Color fundus image:
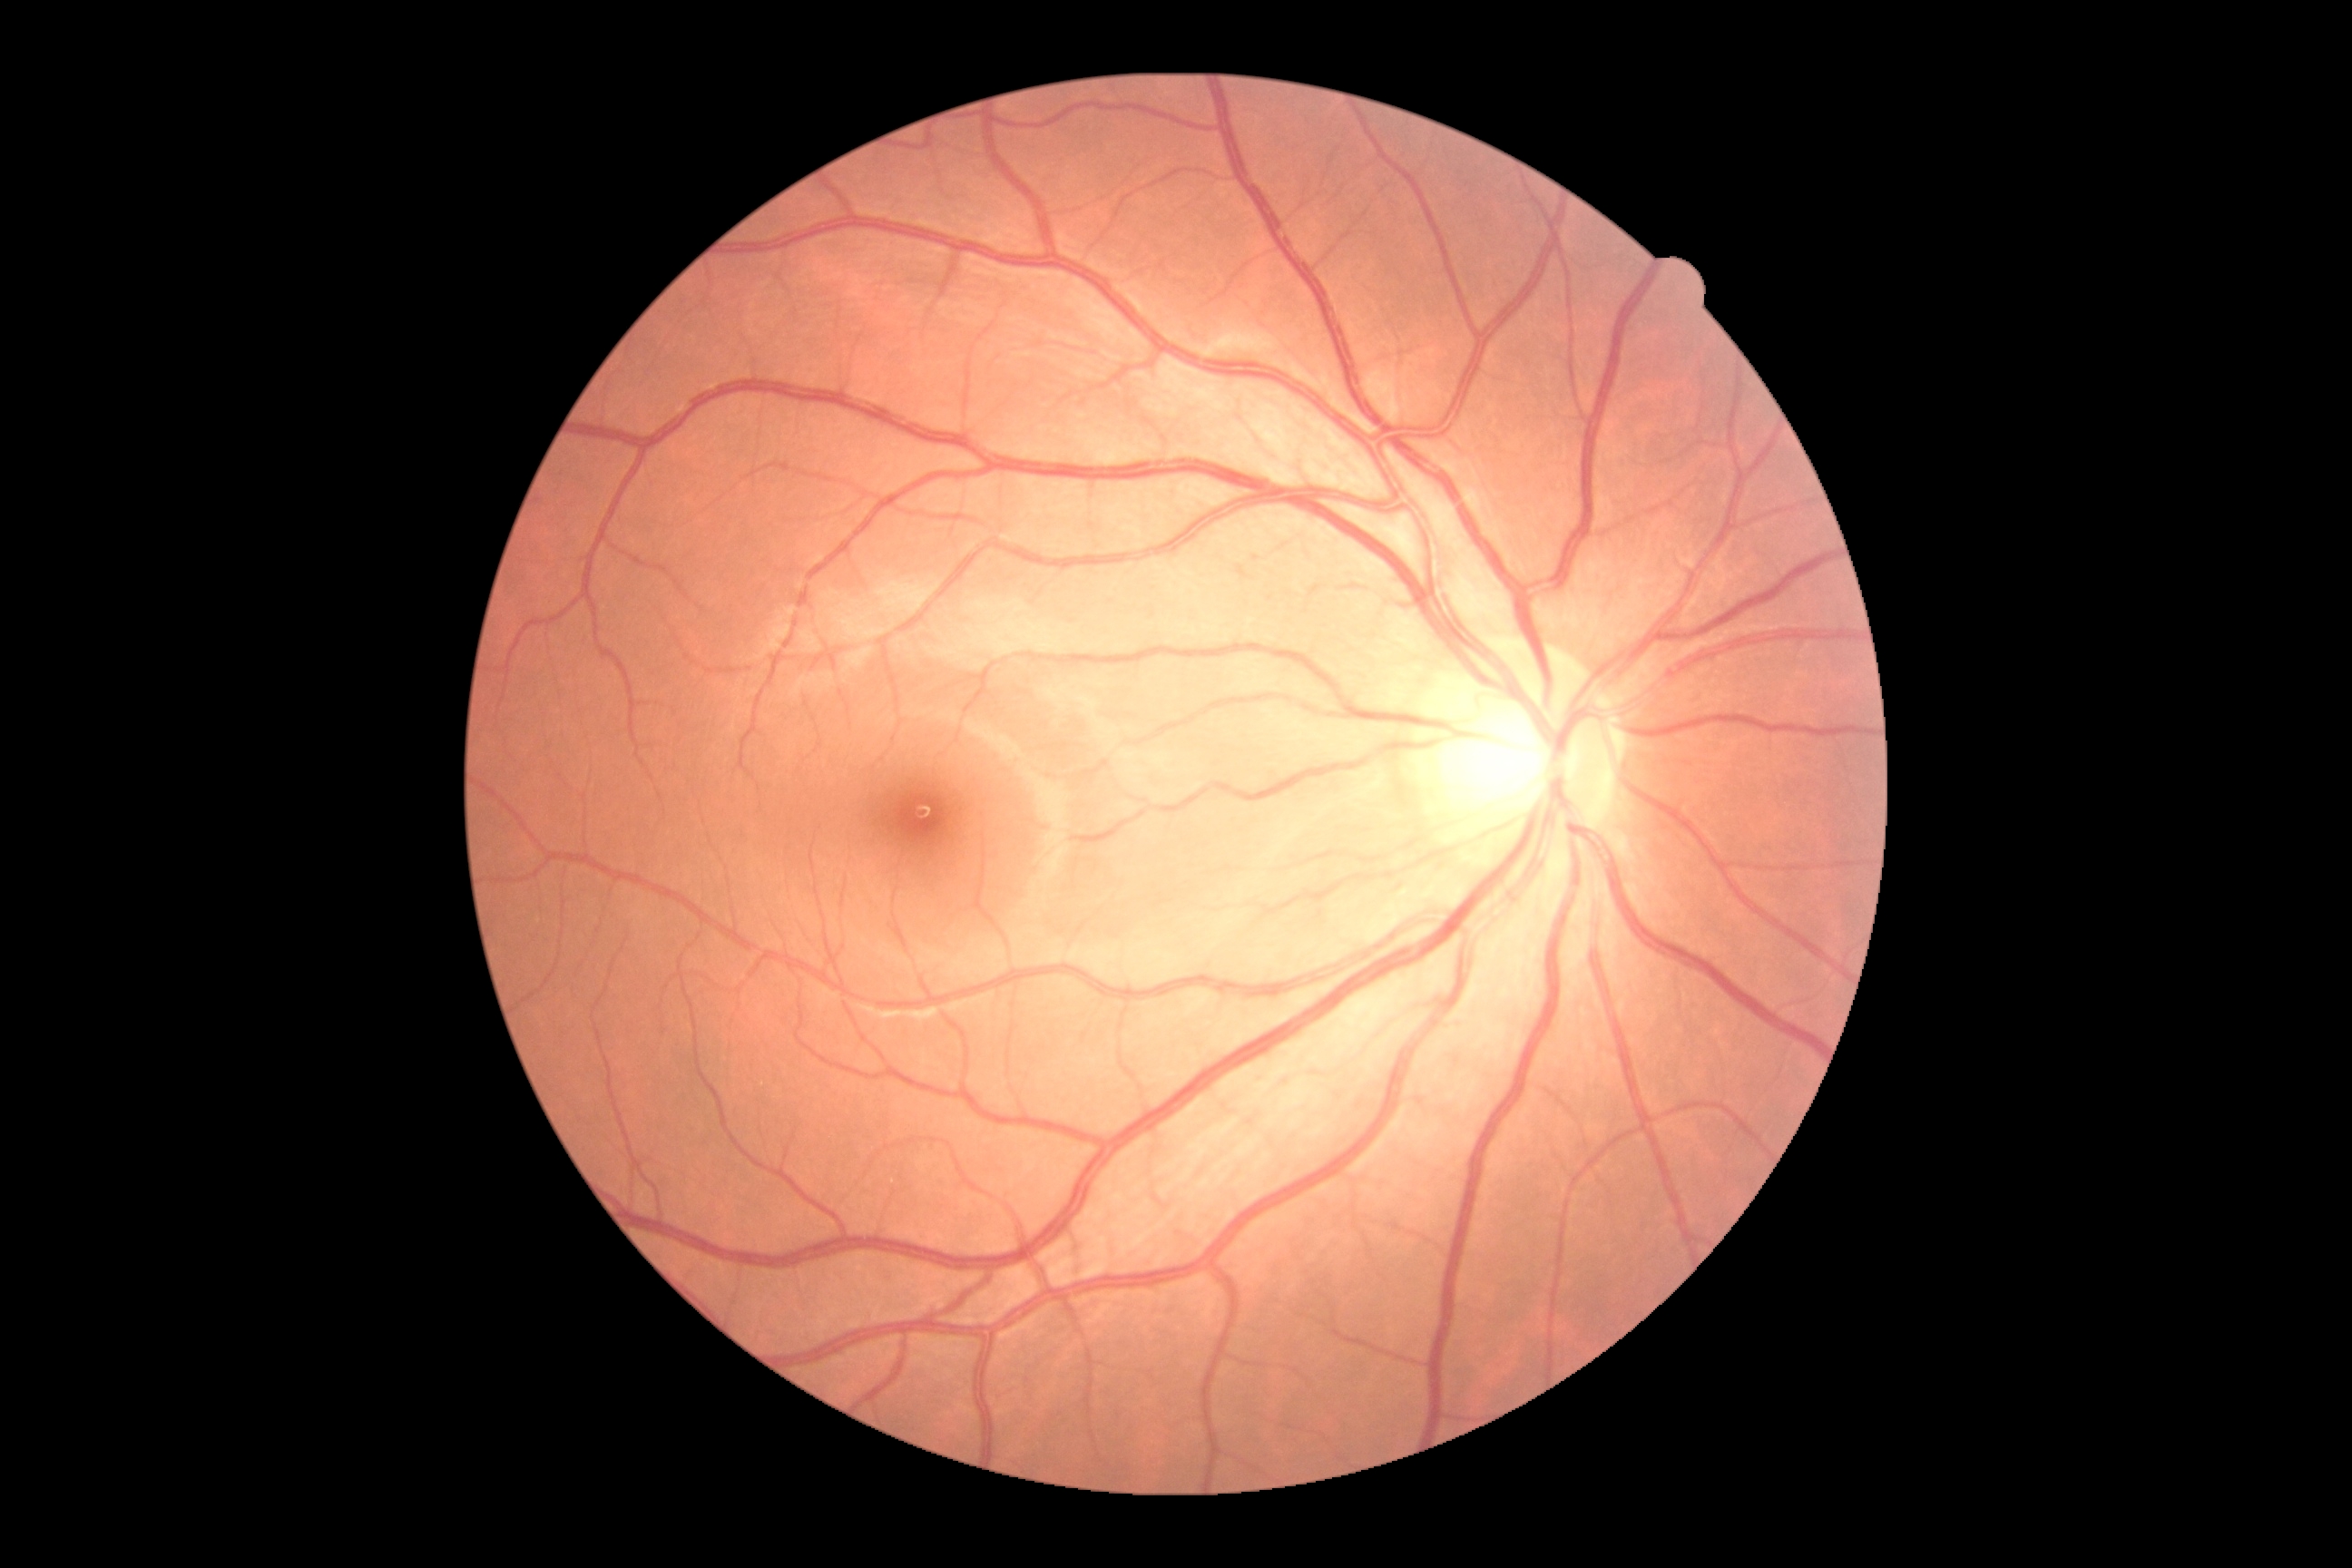
DR grade: 0. No DR findings.